FOV: 45 degrees. Diabetic retinopathy graded by the modified Davis classification — 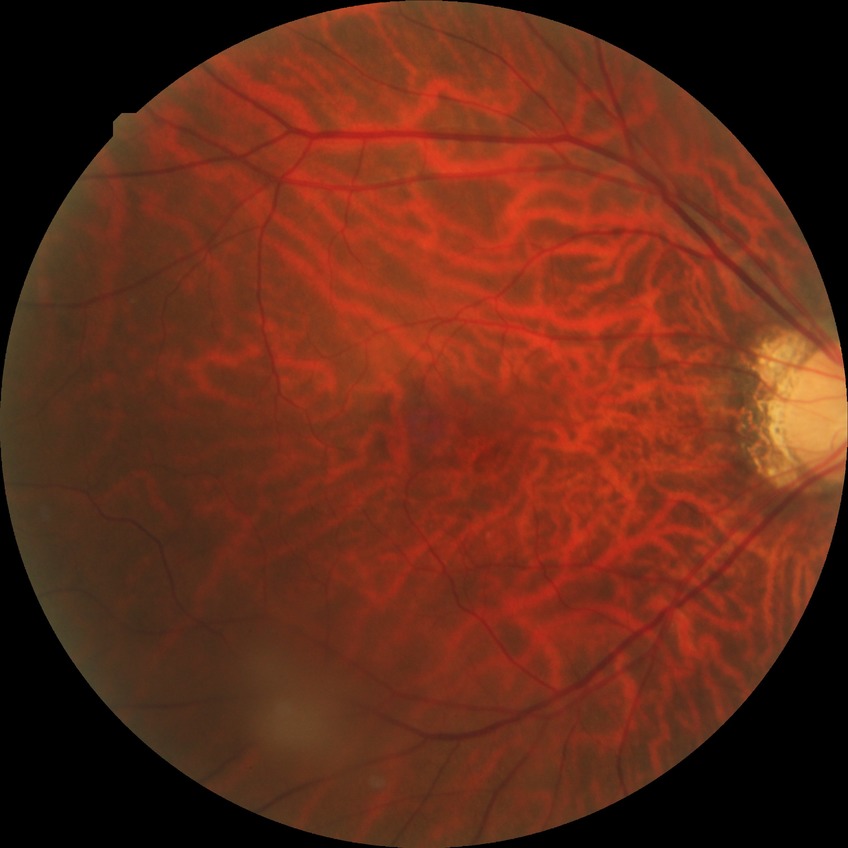
{"davis_grade": "NDR"}